Acquired with a NIDEK AFC-230 · 45 degree fundus photograph.
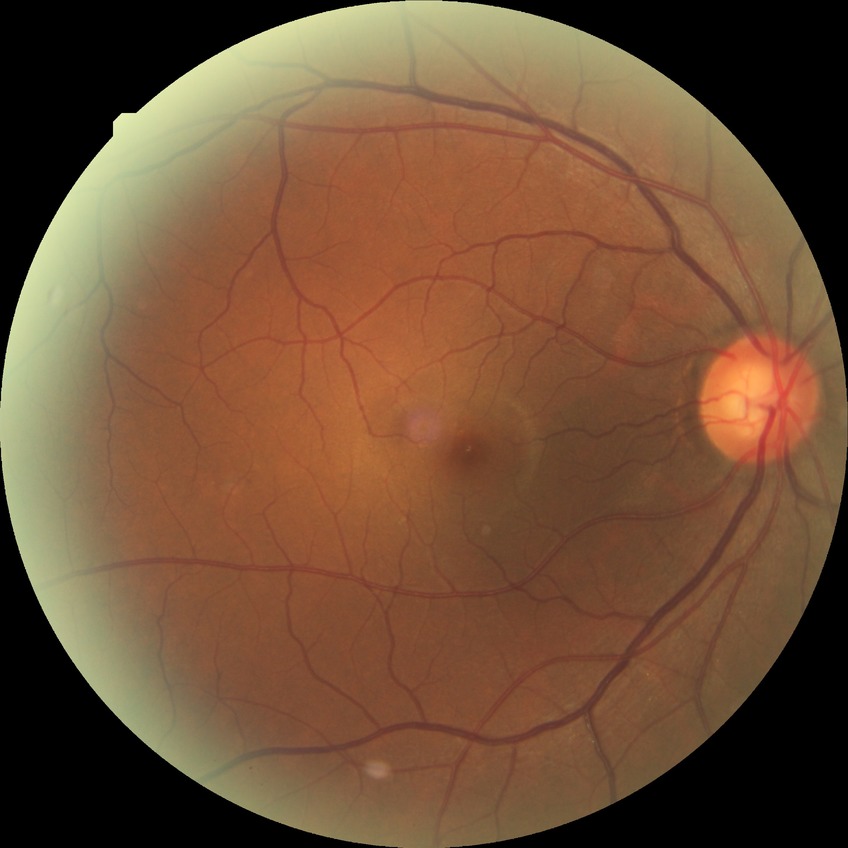

Diabetic retinopathy (DR) is no diabetic retinopathy (NDR).